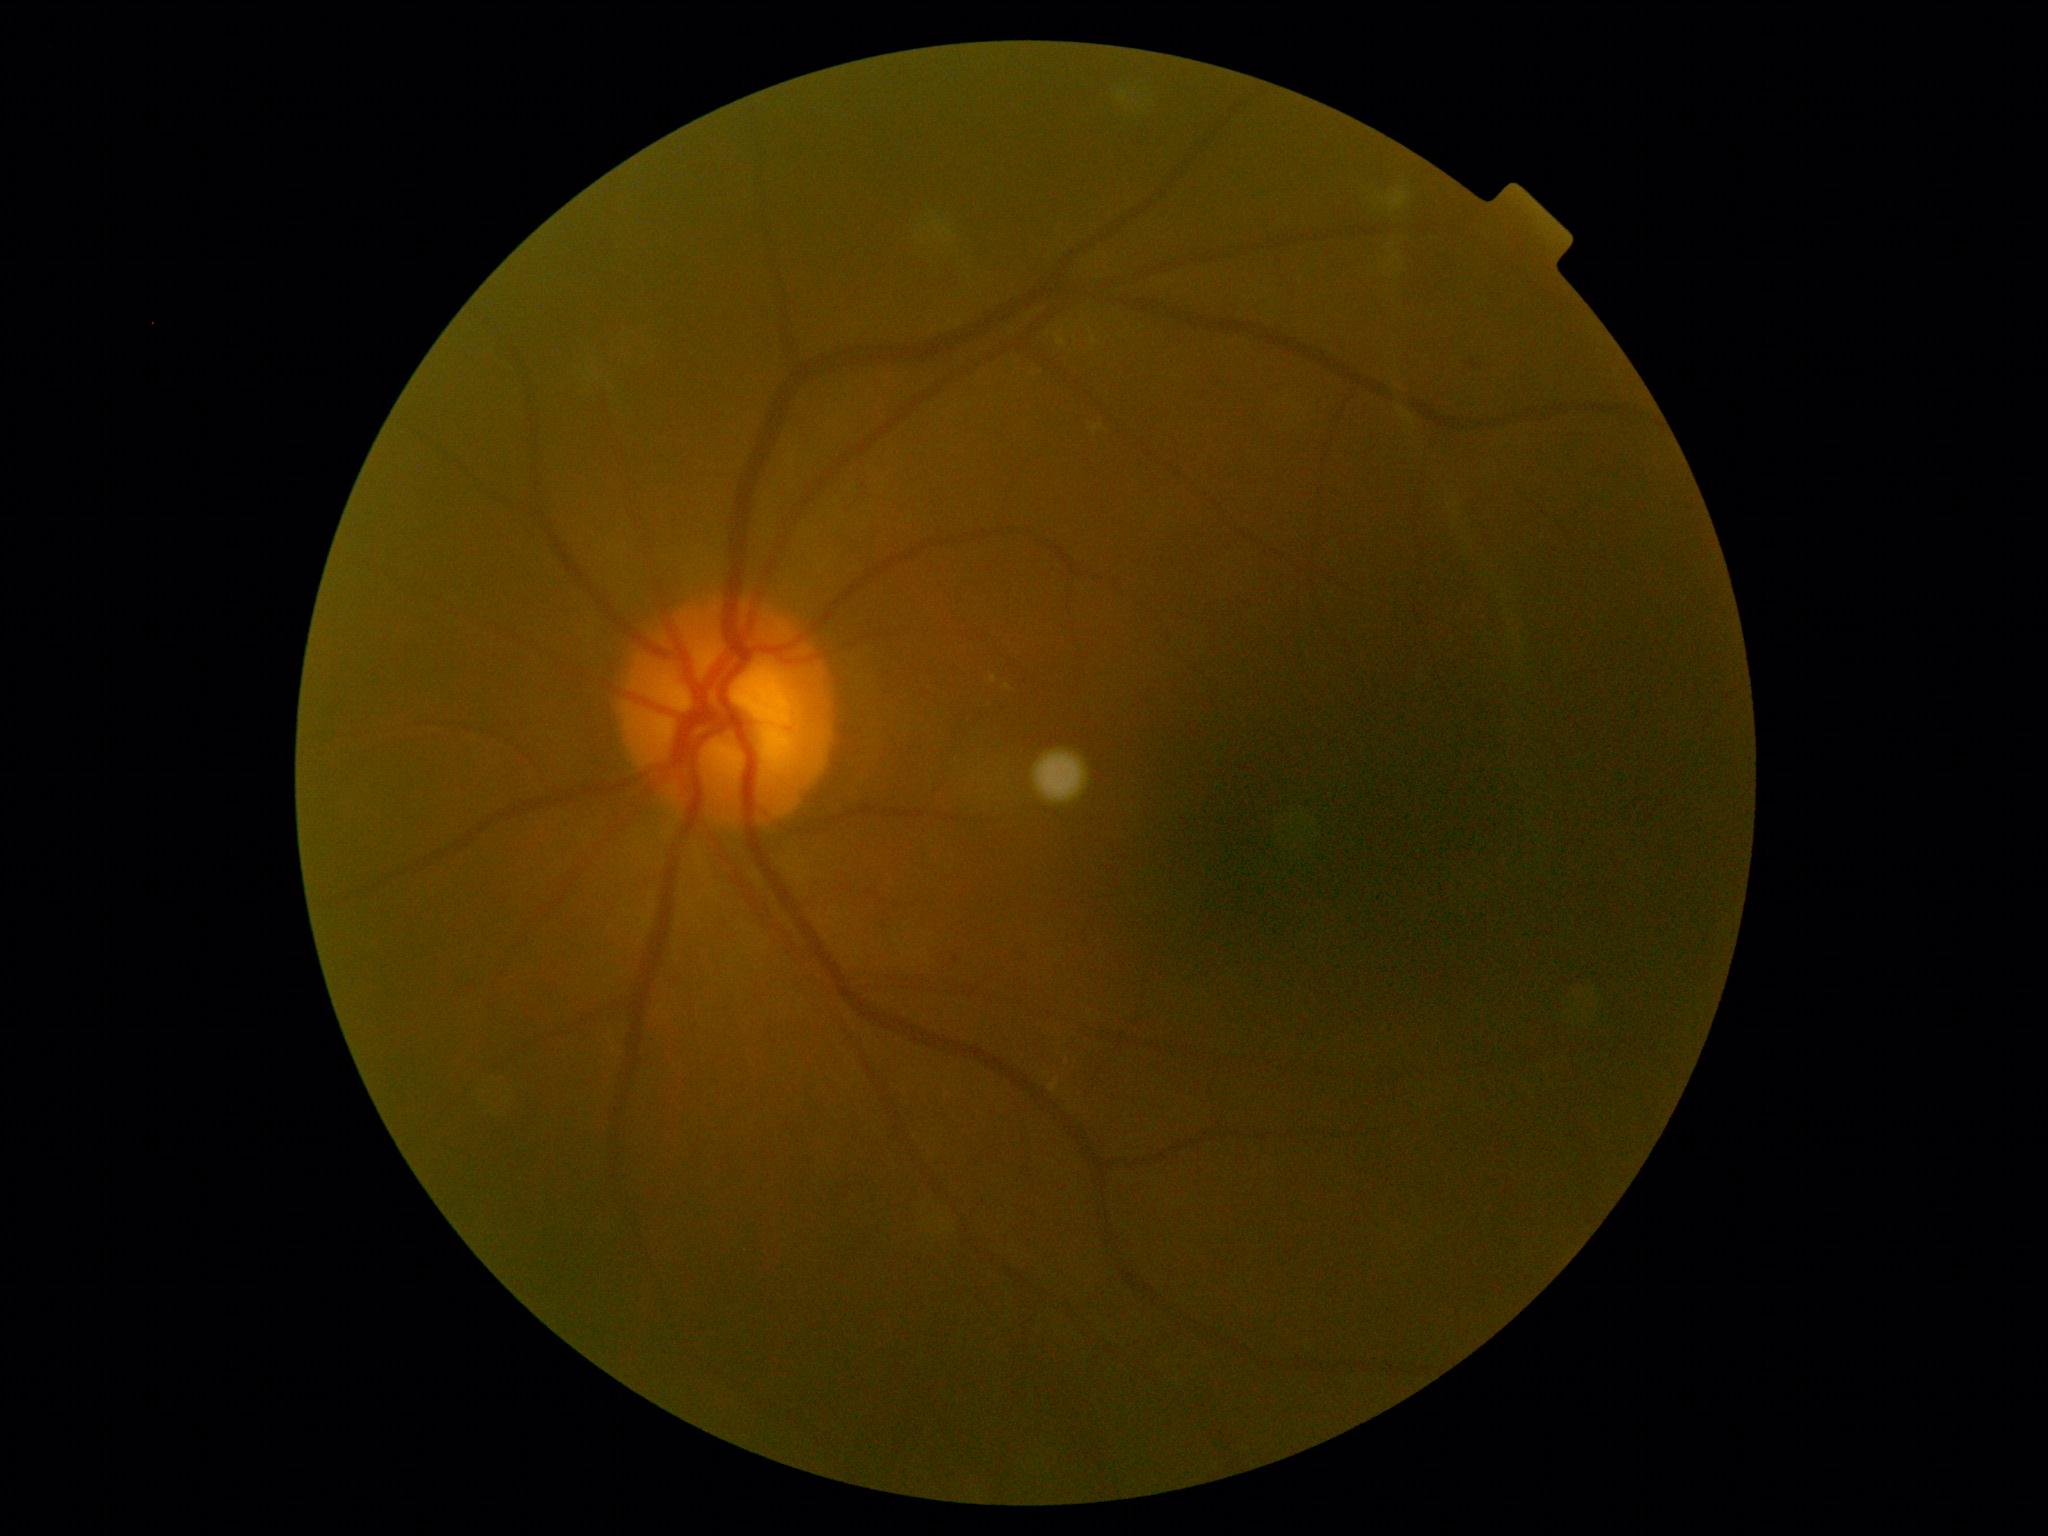
Retinopathy is grade 2 (moderate NPDR) — more than just microaneurysms but less than severe NPDR.